FOV: 45 degrees; fundus photo:
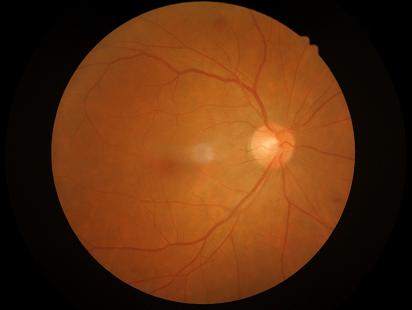
Image quality:
- illumination/color: adequate
- contrast: satisfactory